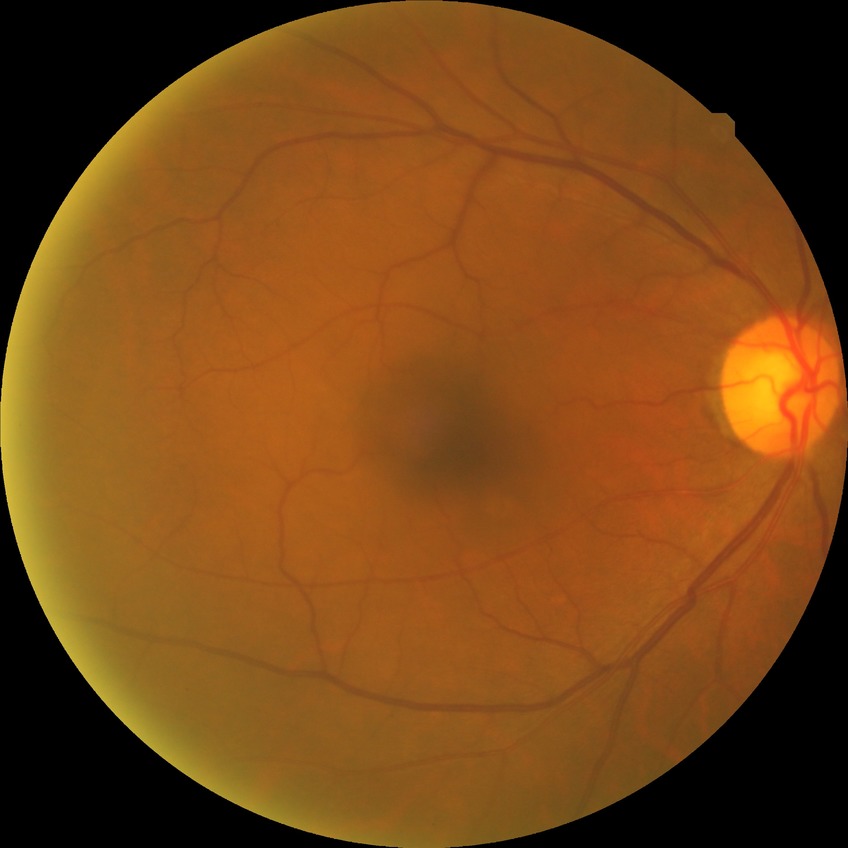
diabetic retinopathy grade = no diabetic retinopathy